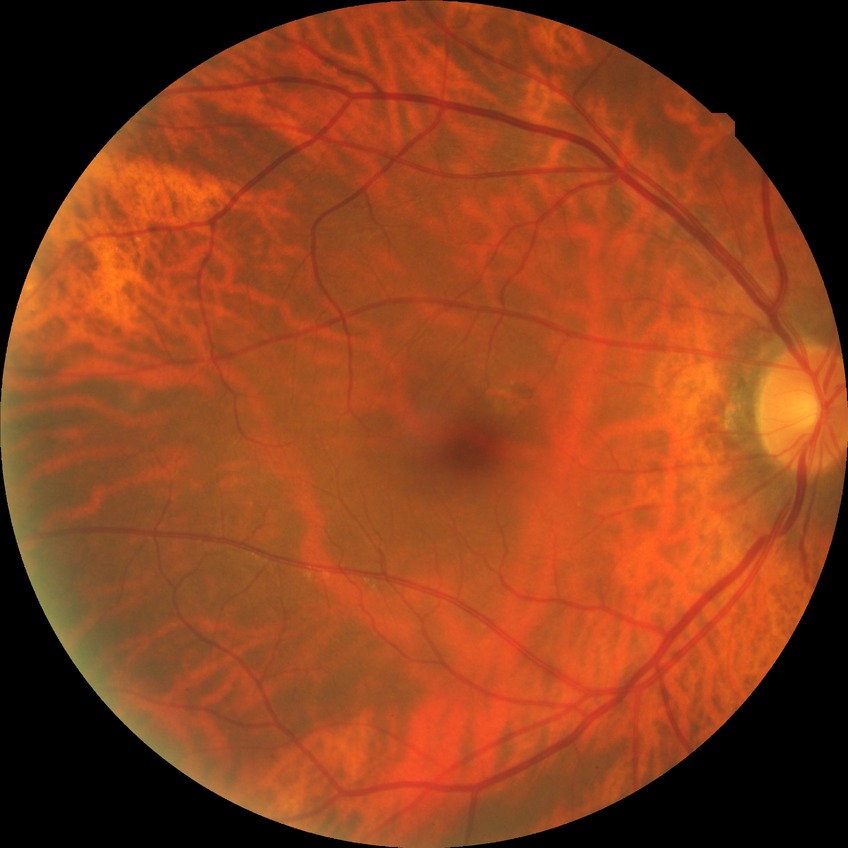

Diabetic retinopathy stage: no diabetic retinopathy.